Retinal fundus photograph — 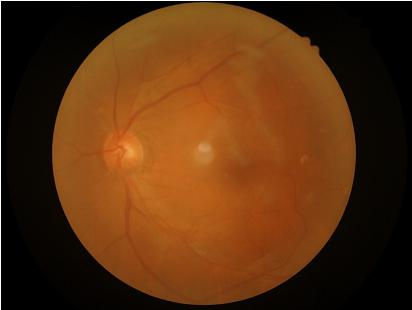
Image quality assessment:
- illumination: even
- overall: good
- clarity: poor